Modified Davis grading; 45-degree field of view; nonmydriatic:
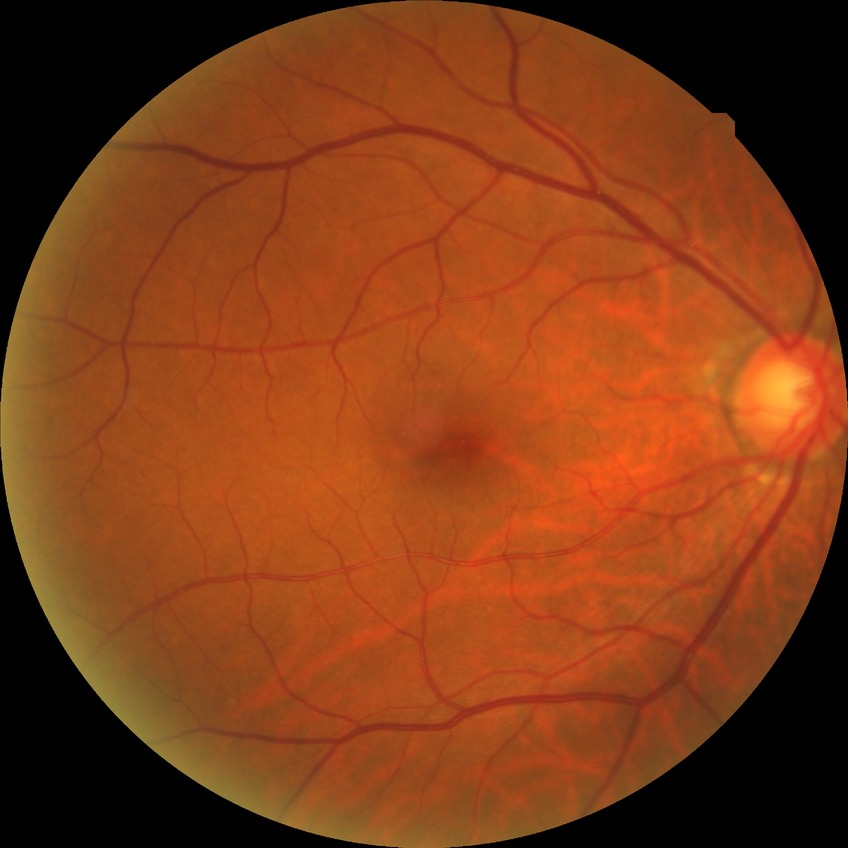 {"davis_grade": "no diabetic retinopathy (NDR)"}